Diabetic retinopathy graded by the modified Davis classification:
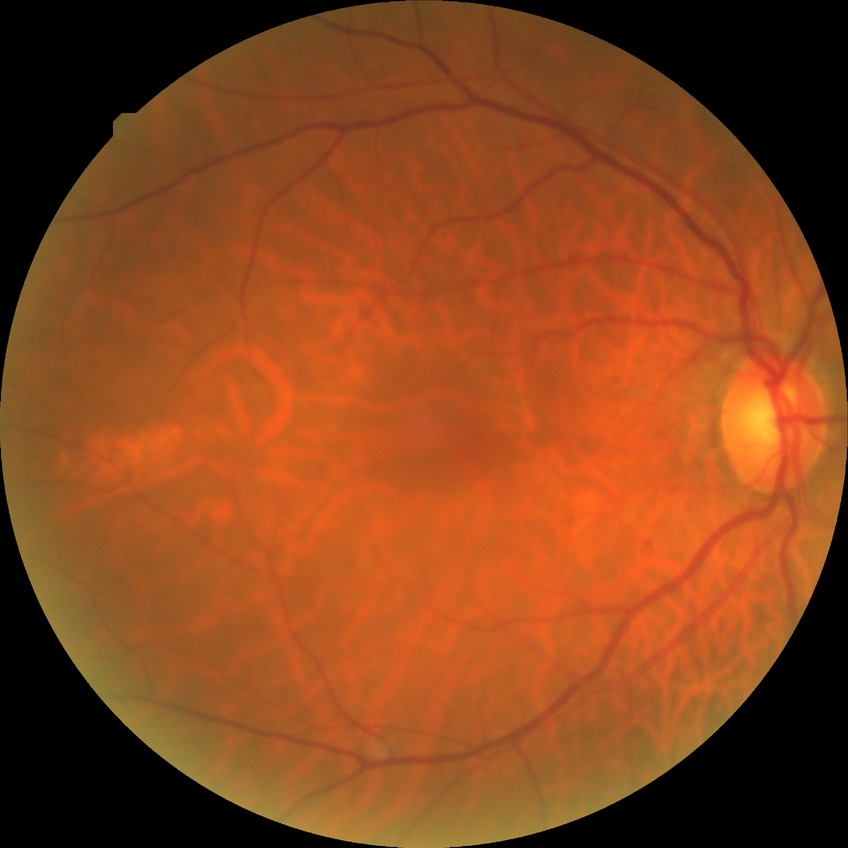 diabetic retinopathy (DR)@PPDR (pre-proliferative diabetic retinopathy).